RetCam wide-field infant fundus image. 1440x1080px
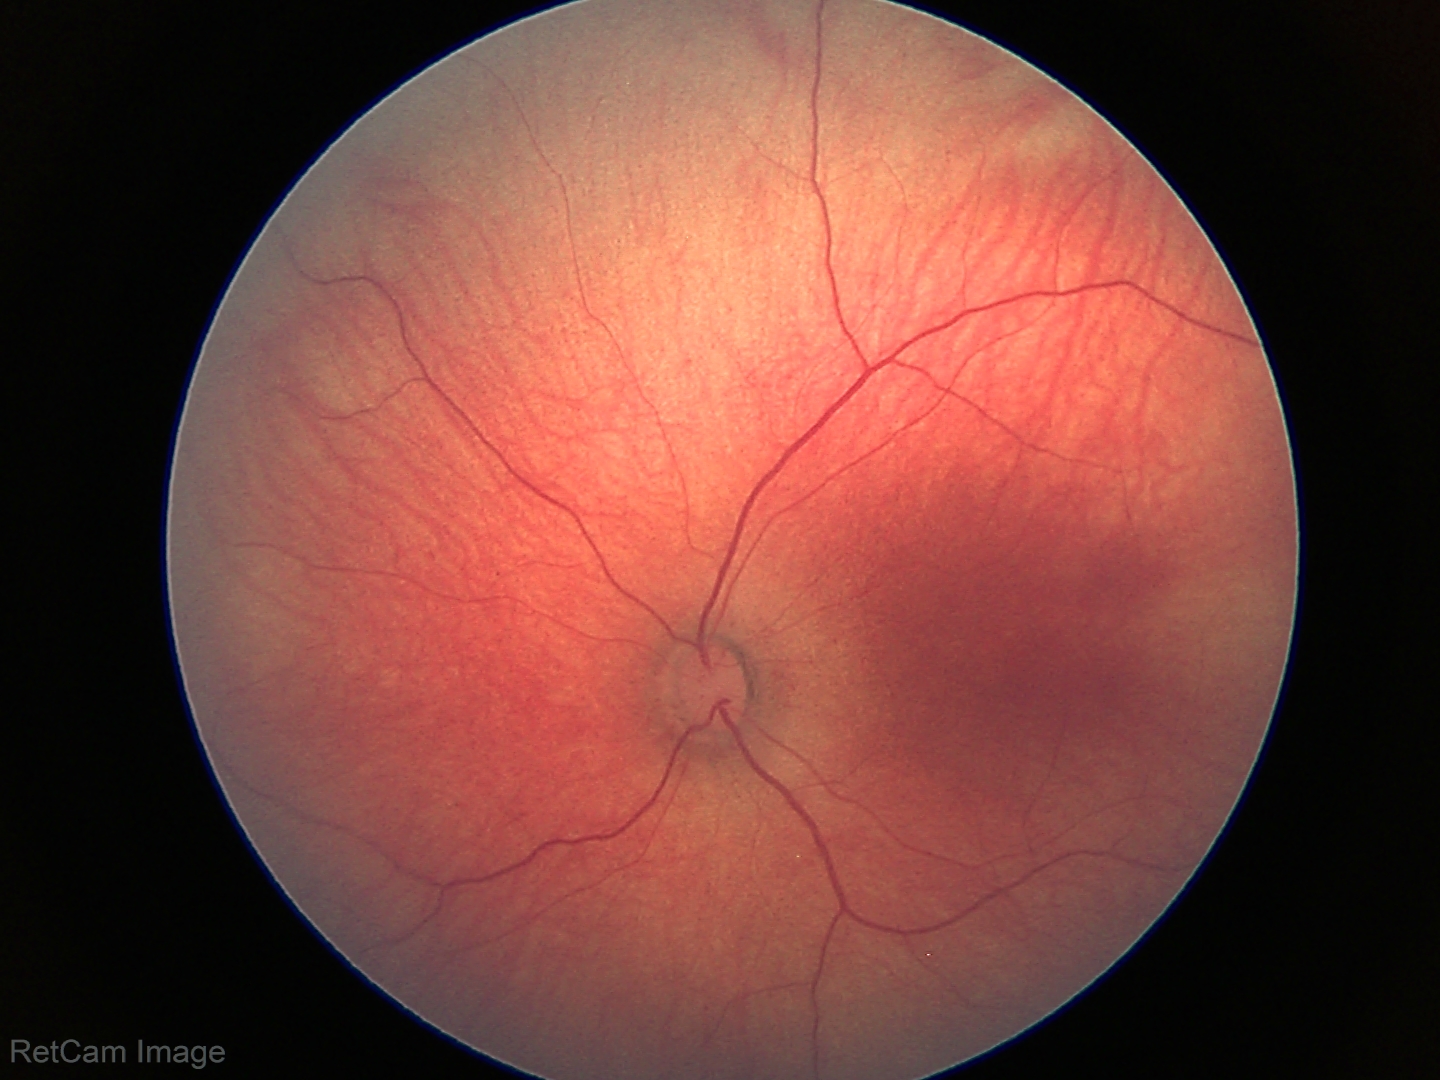
Impression: normal fundus examination.